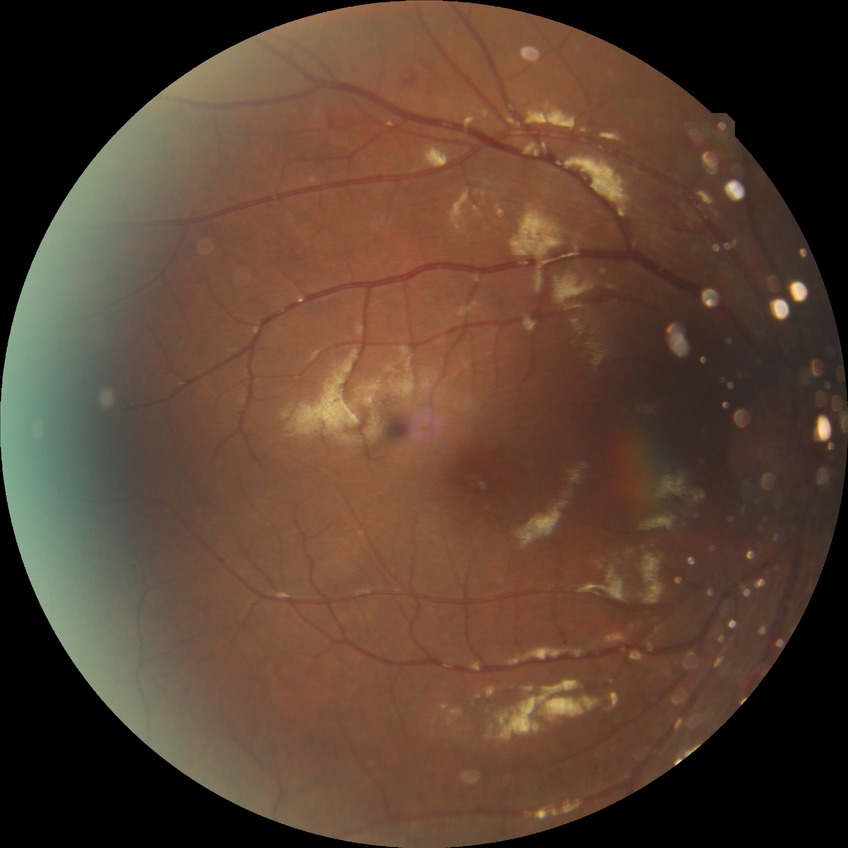
DR grade: SDR.